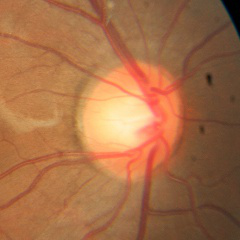 No glaucomatous changes.